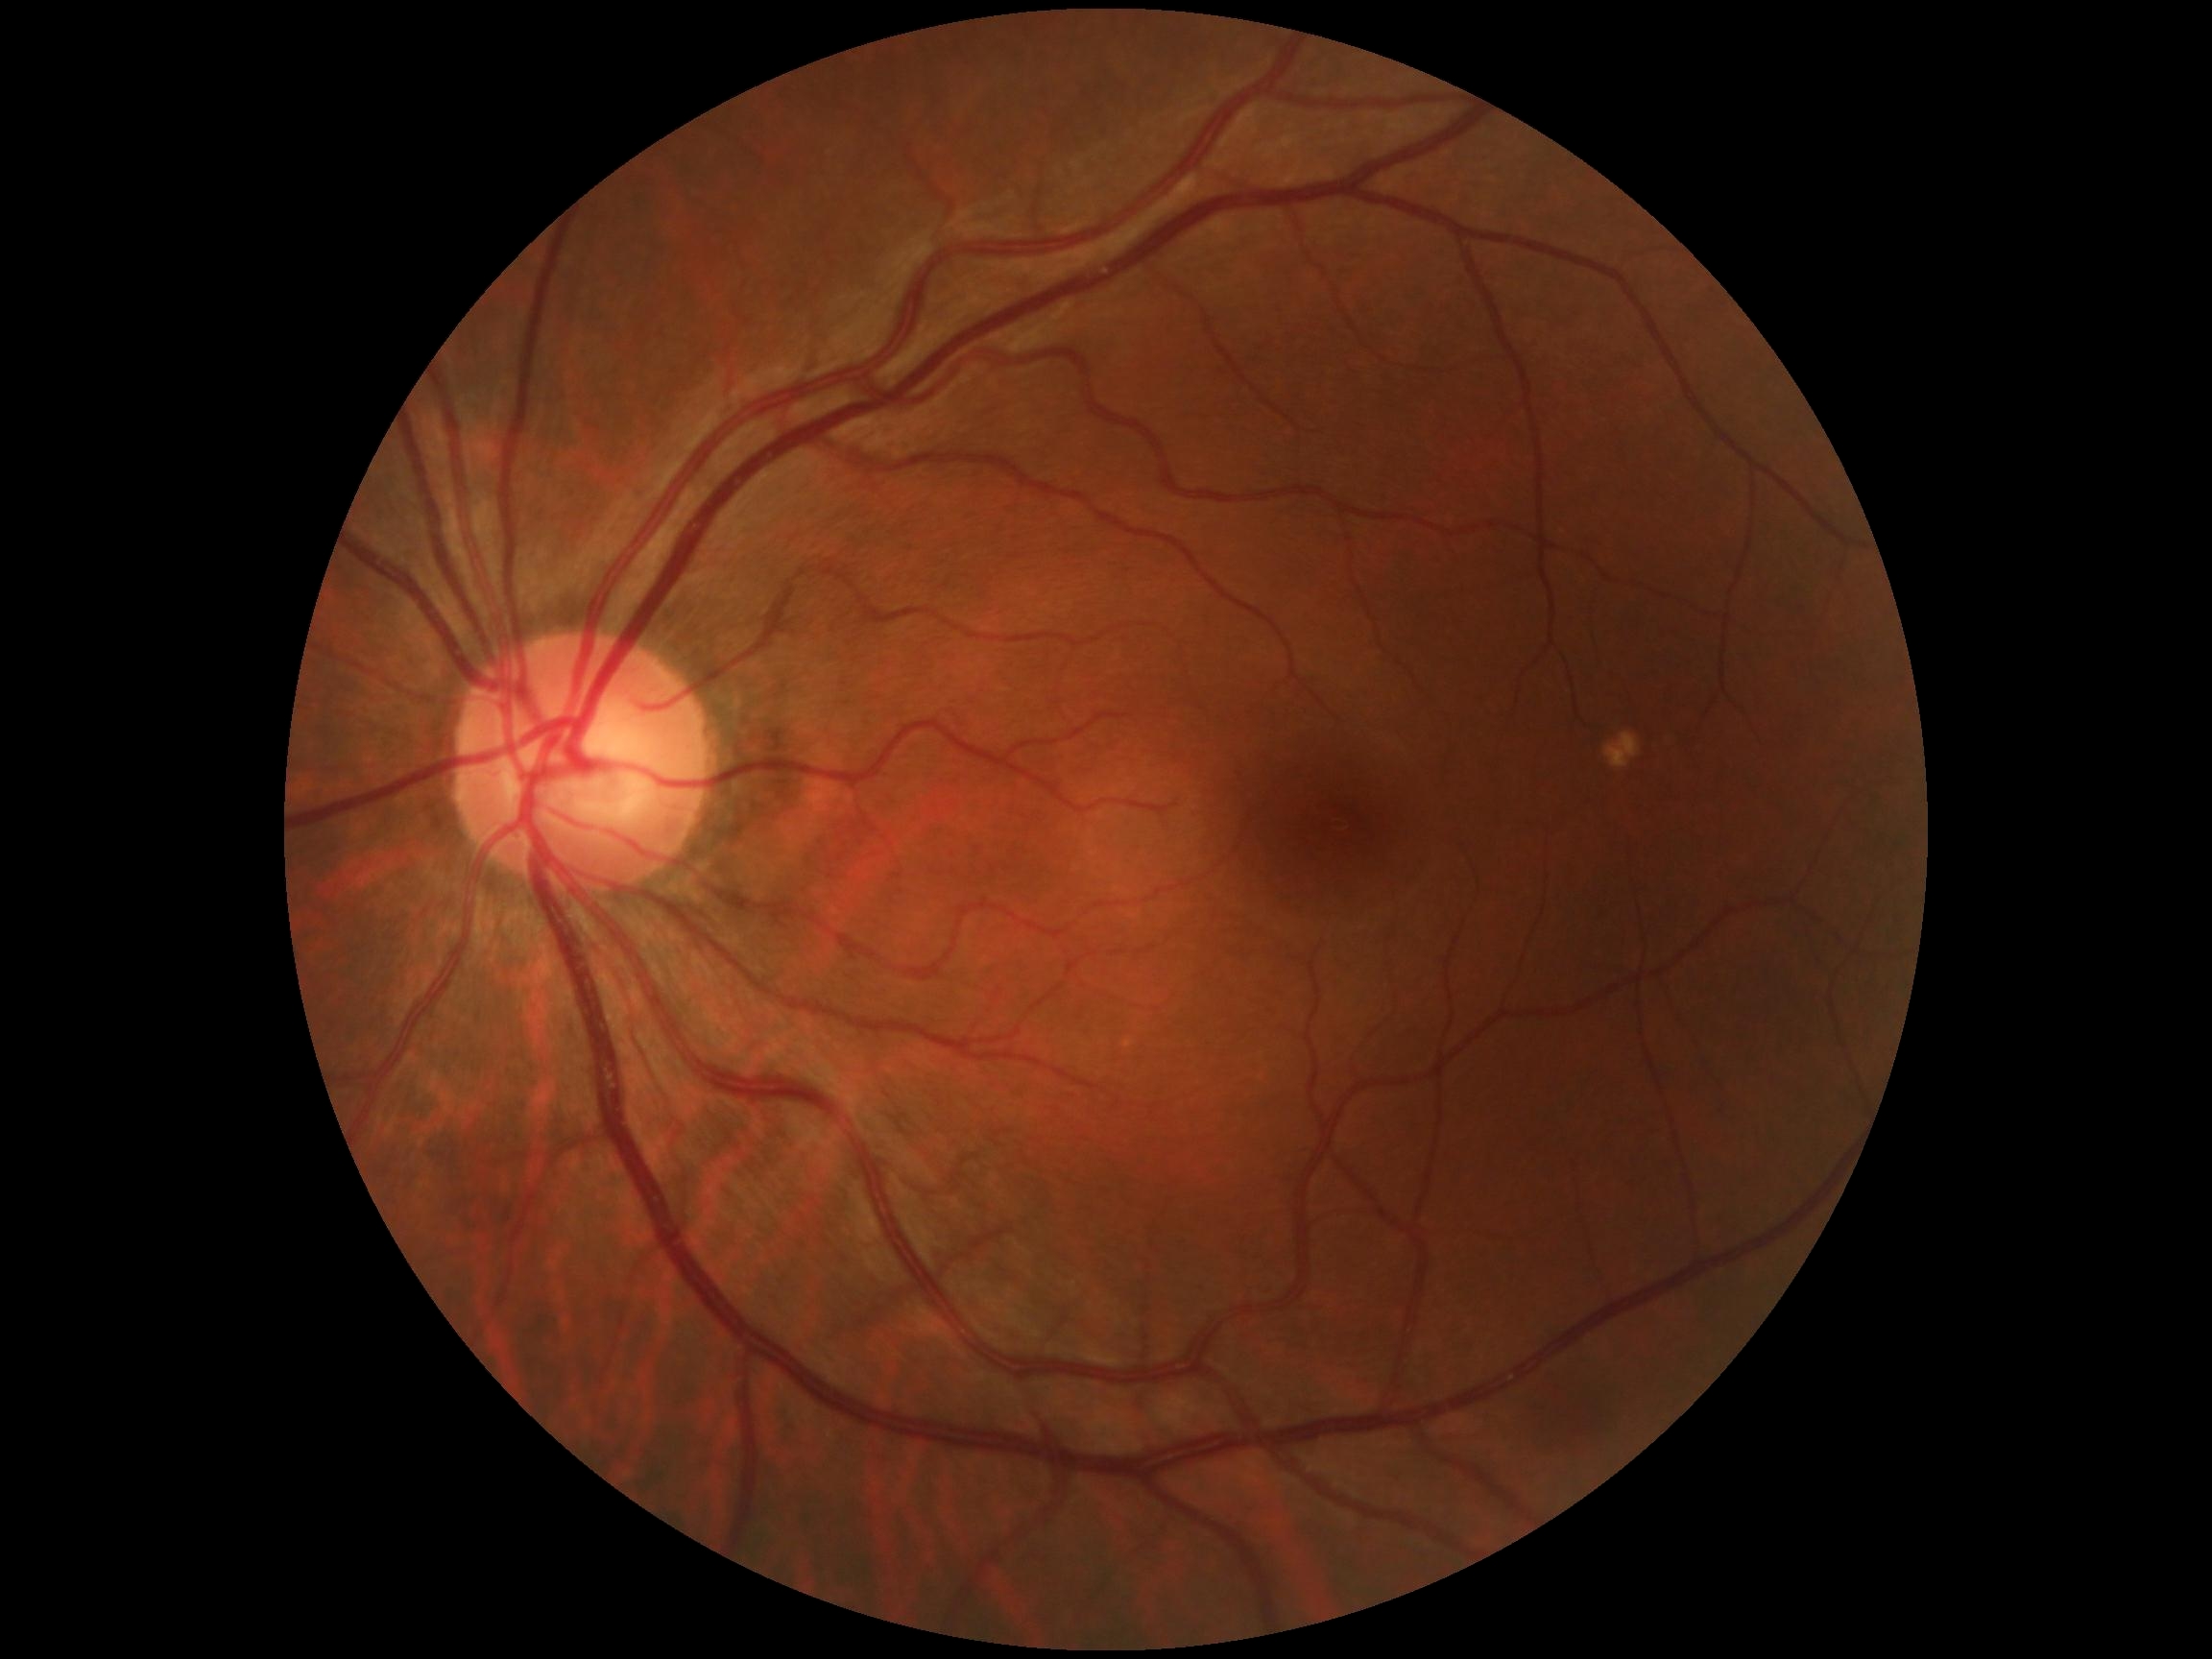 DR severity: 0.